Infant wide-field retinal image.
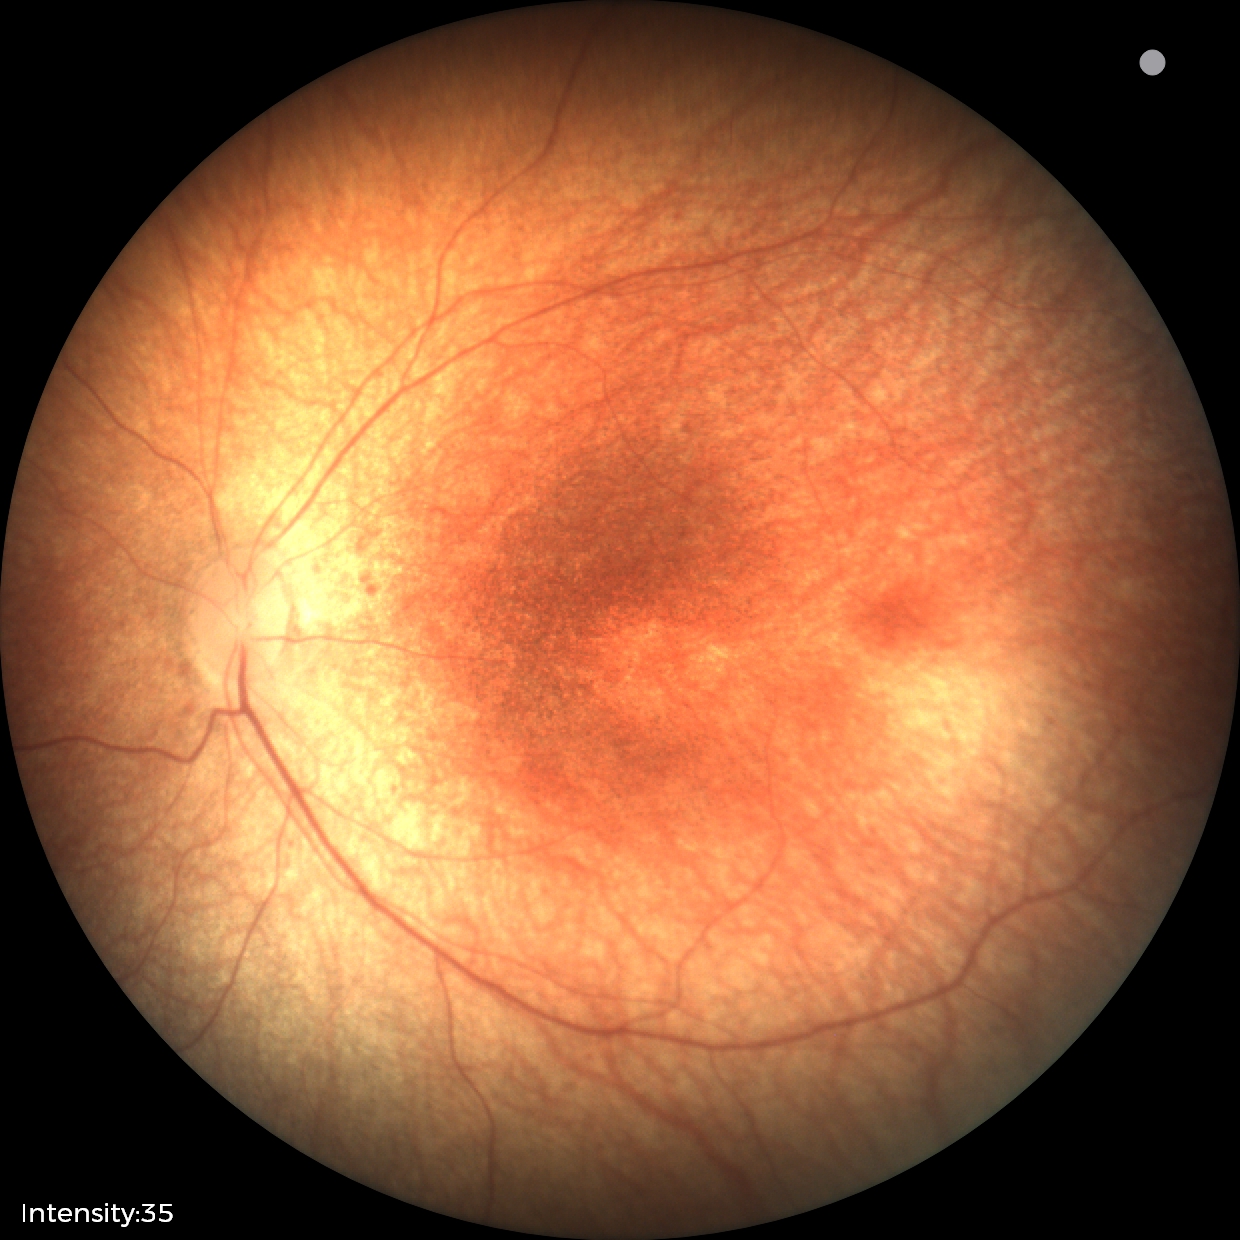 Diagnosis = no abnormalities.